Pediatric retinal photograph (wide-field).
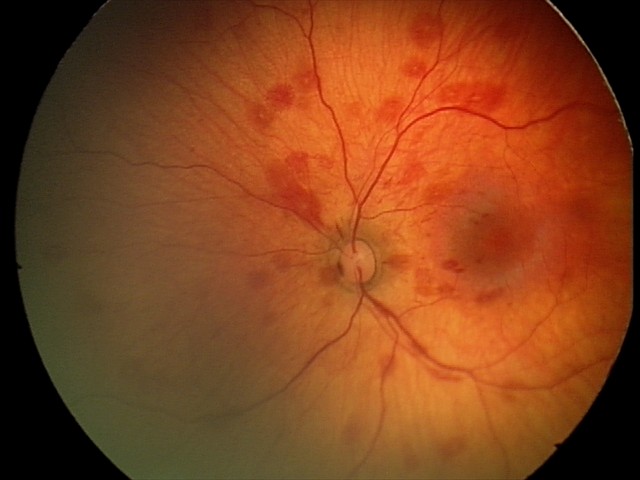 Screening examination consistent with retinal hemorrhages.